2048x1536px; CFP.
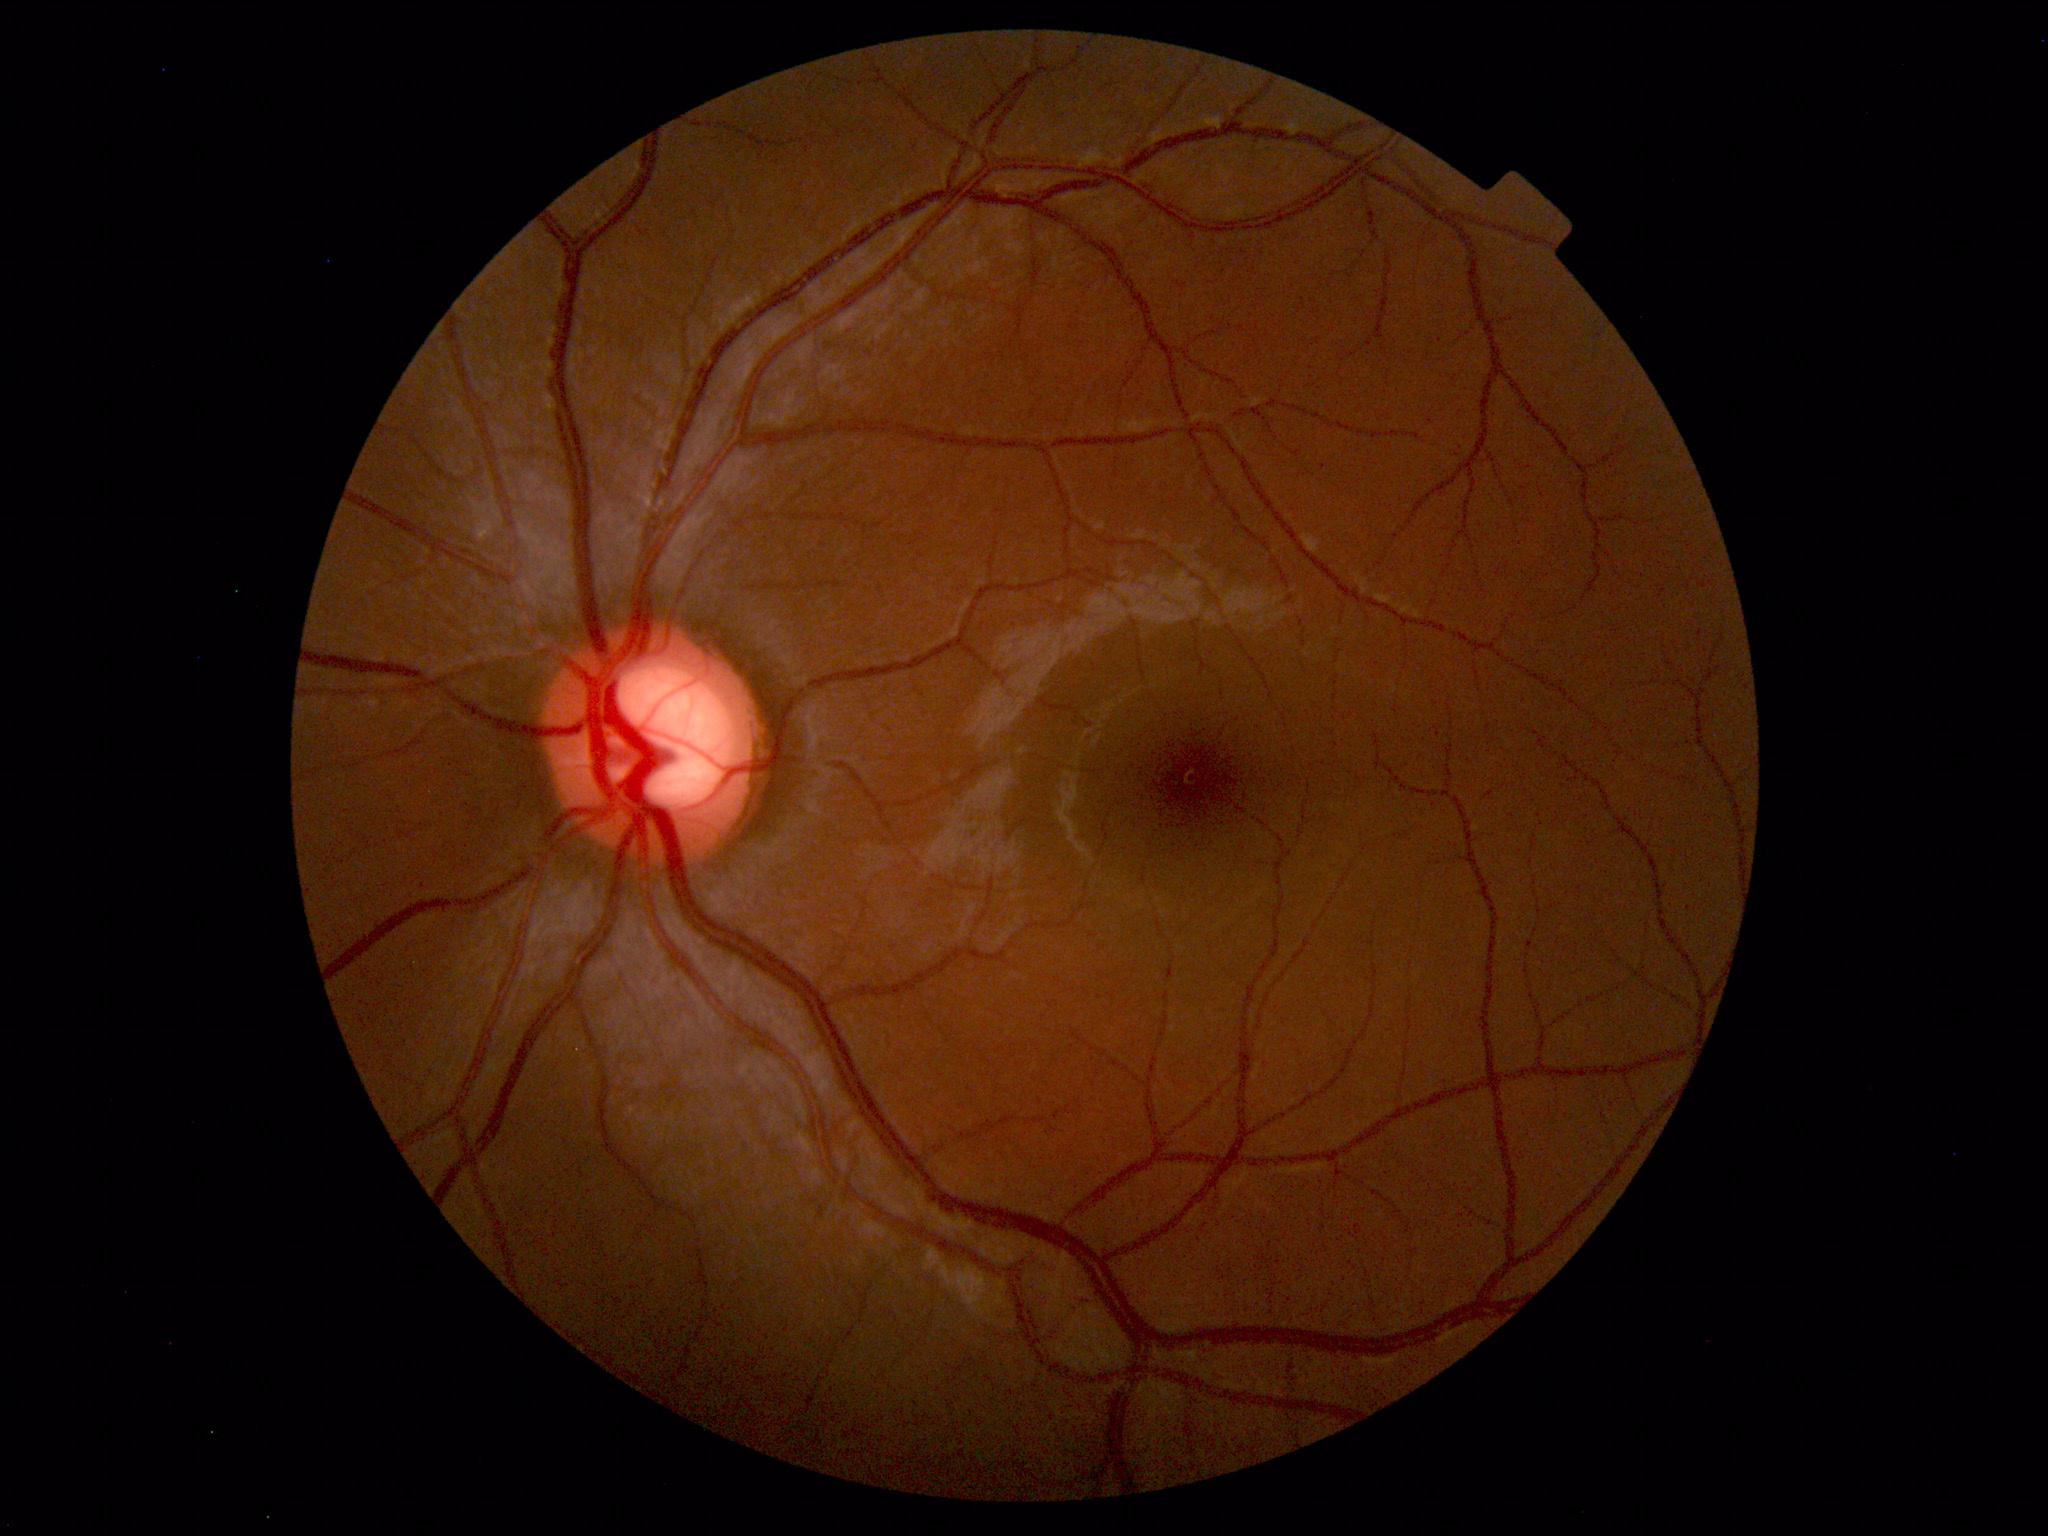 The fundus appears normal with no pathological findings.